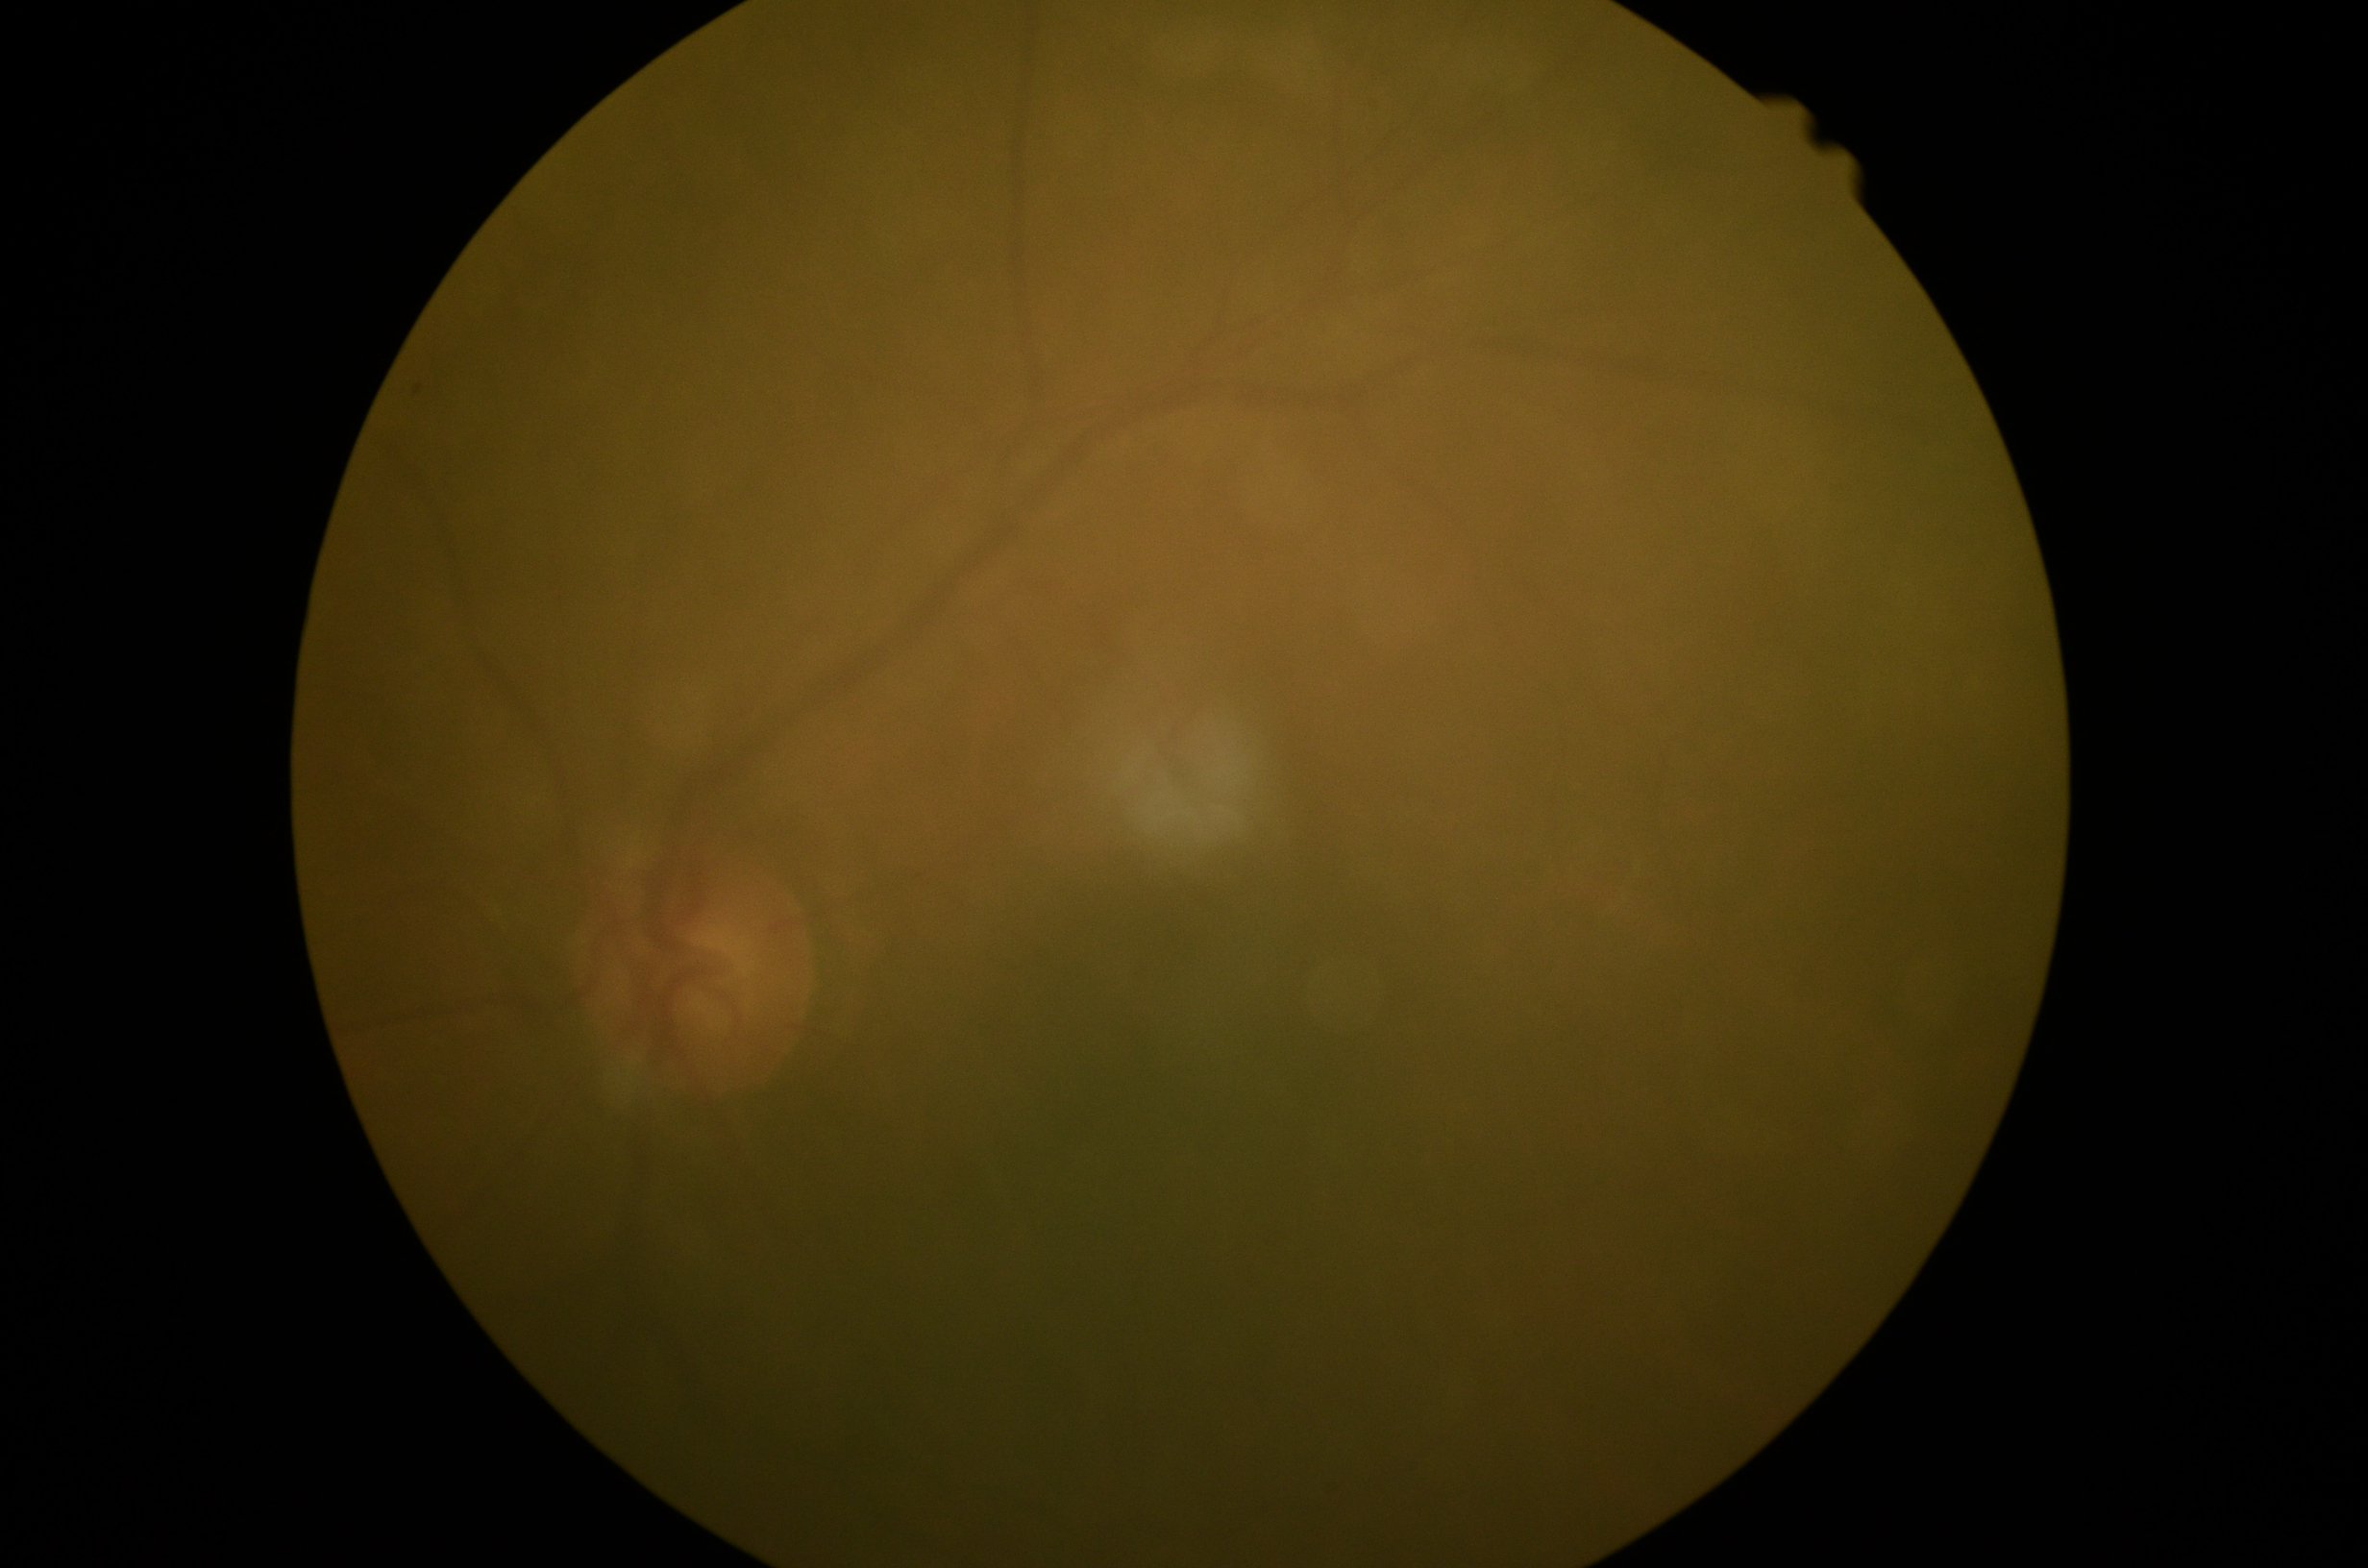

retinopathy grade@ungradable due to poor image quality, image quality@below grading threshold.